Disc-centered fundus crop: 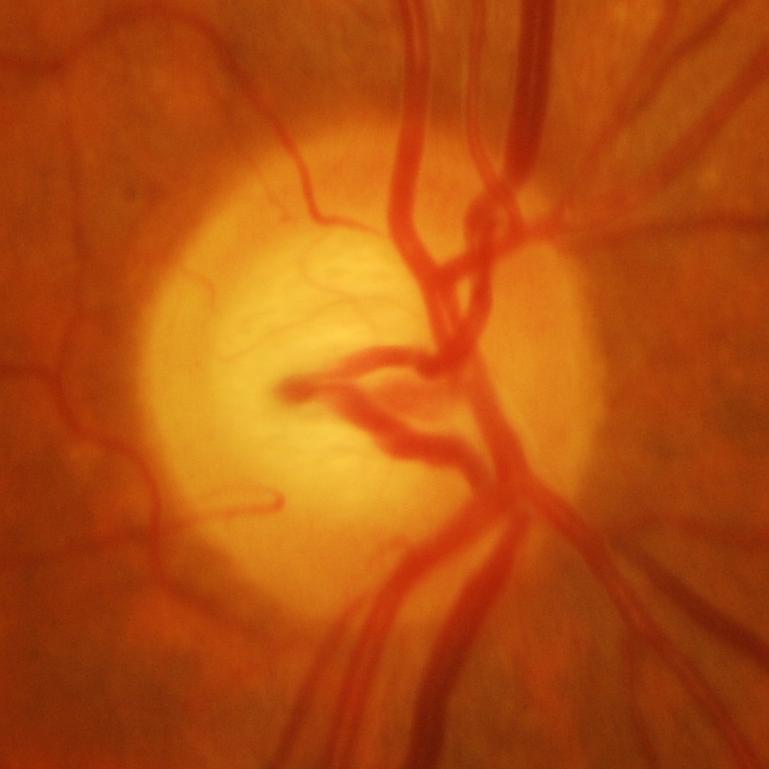 Glaucomatous changes are present. Diagnosis: glaucoma.